NIDEK AFC-230; 45° FOV: 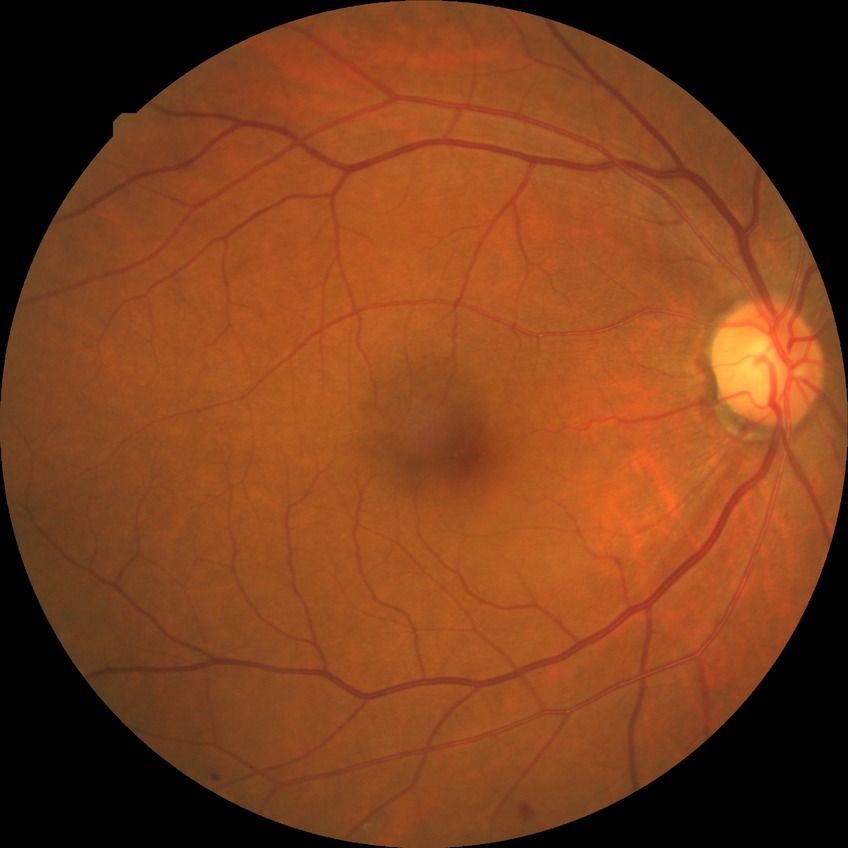
Diabetic retinopathy (DR) is SDR (simple diabetic retinopathy).